Camera: Bosch handheld camera; color fundus photograph — 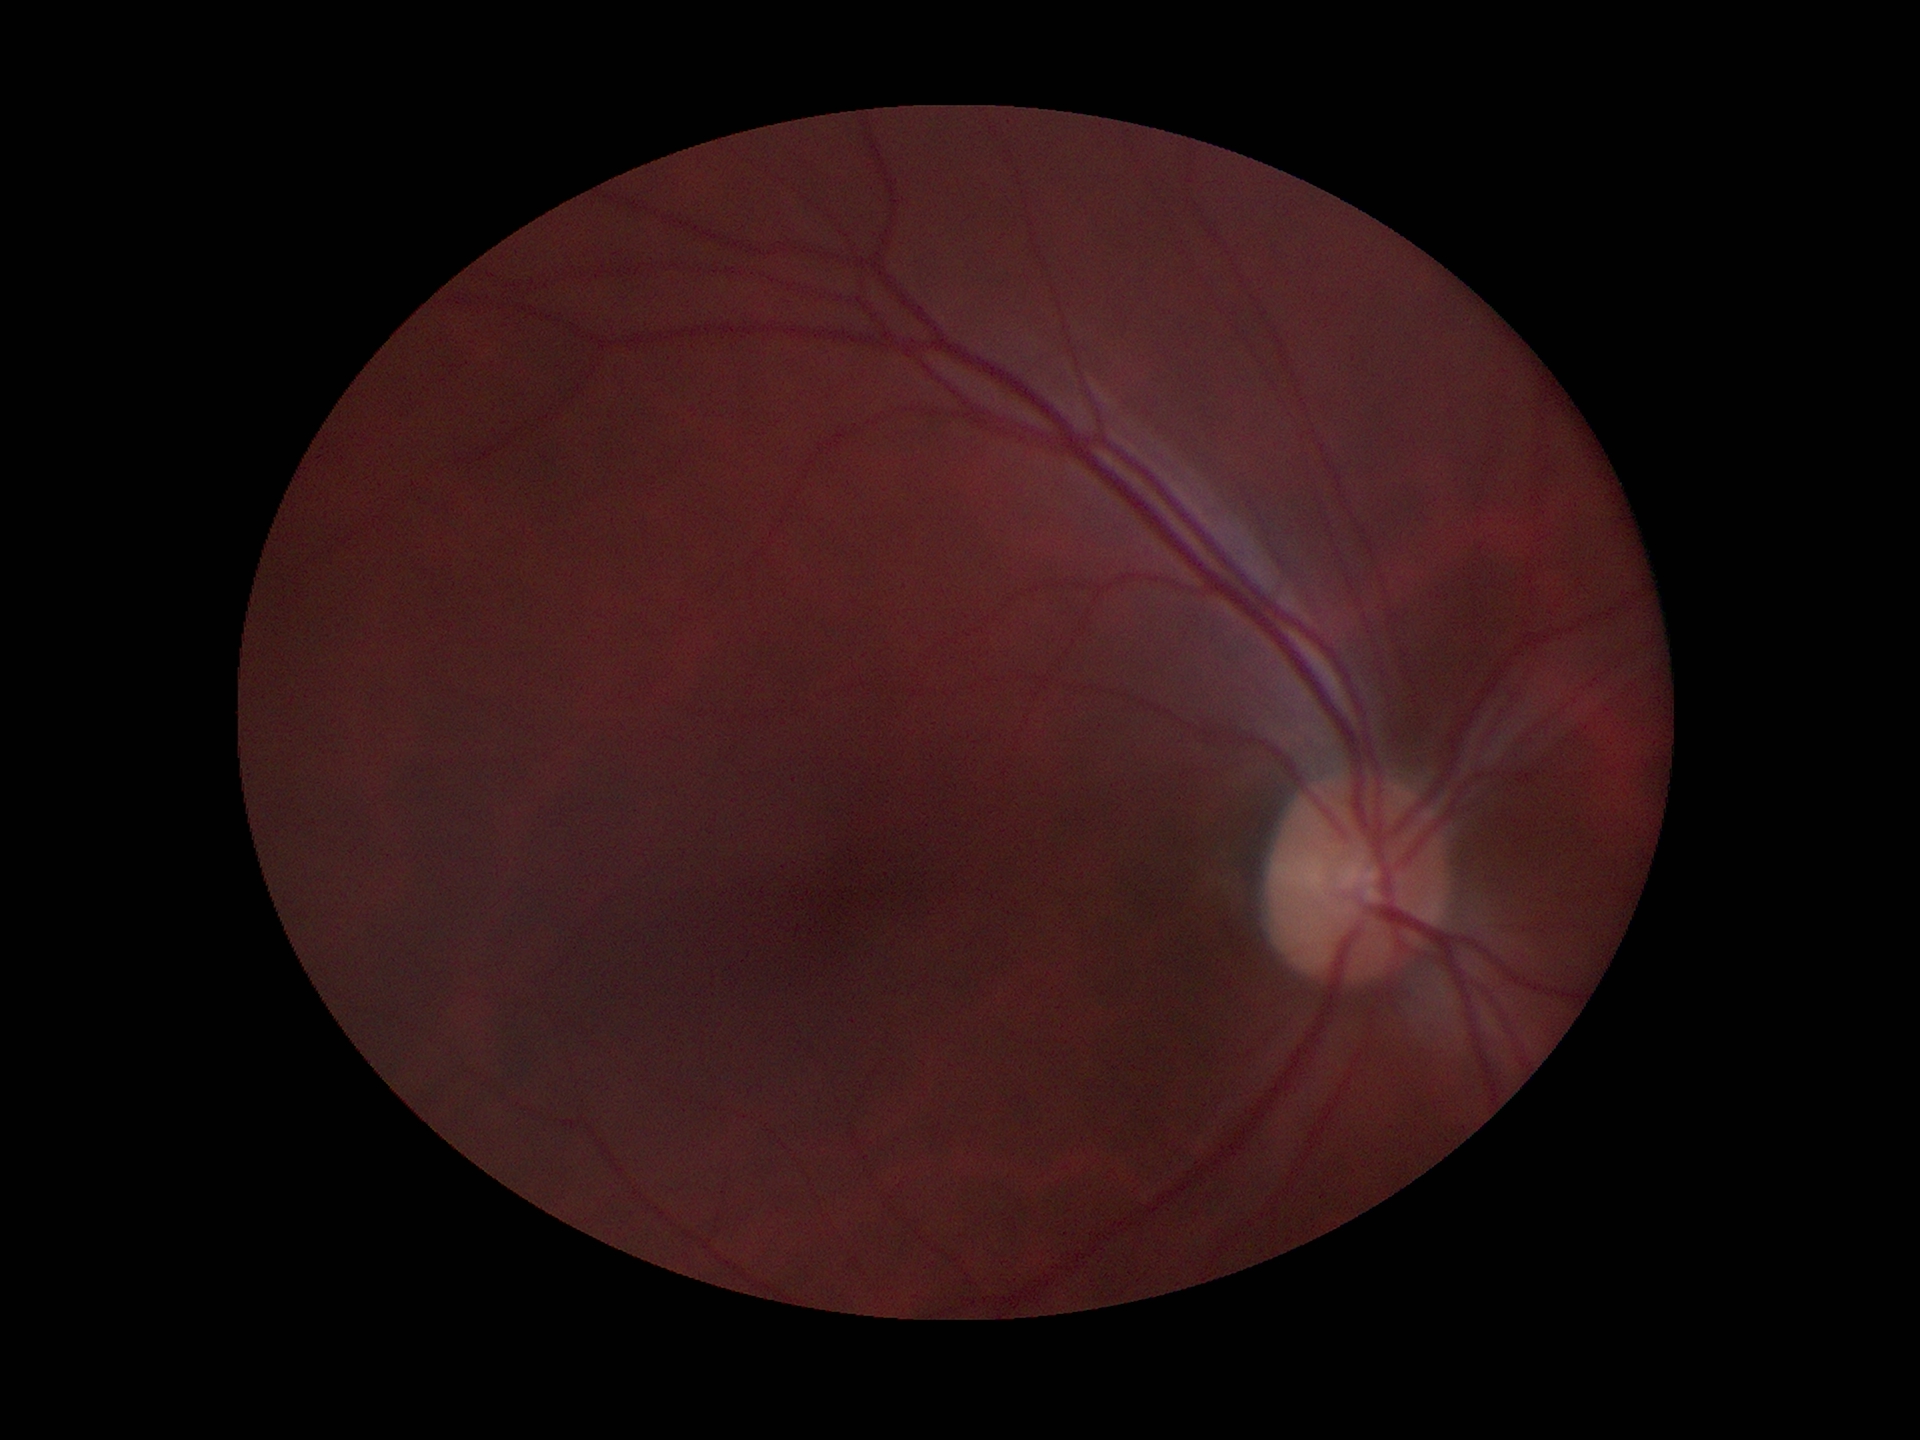 Q: What is the HCDR?
A: 0.52
Q: Is there glaucoma suspicion?
A: negative
Q: What is the vertical cup-to-disc ratio?
A: 0.50